Pupil-dilated; 50-degree field of view: 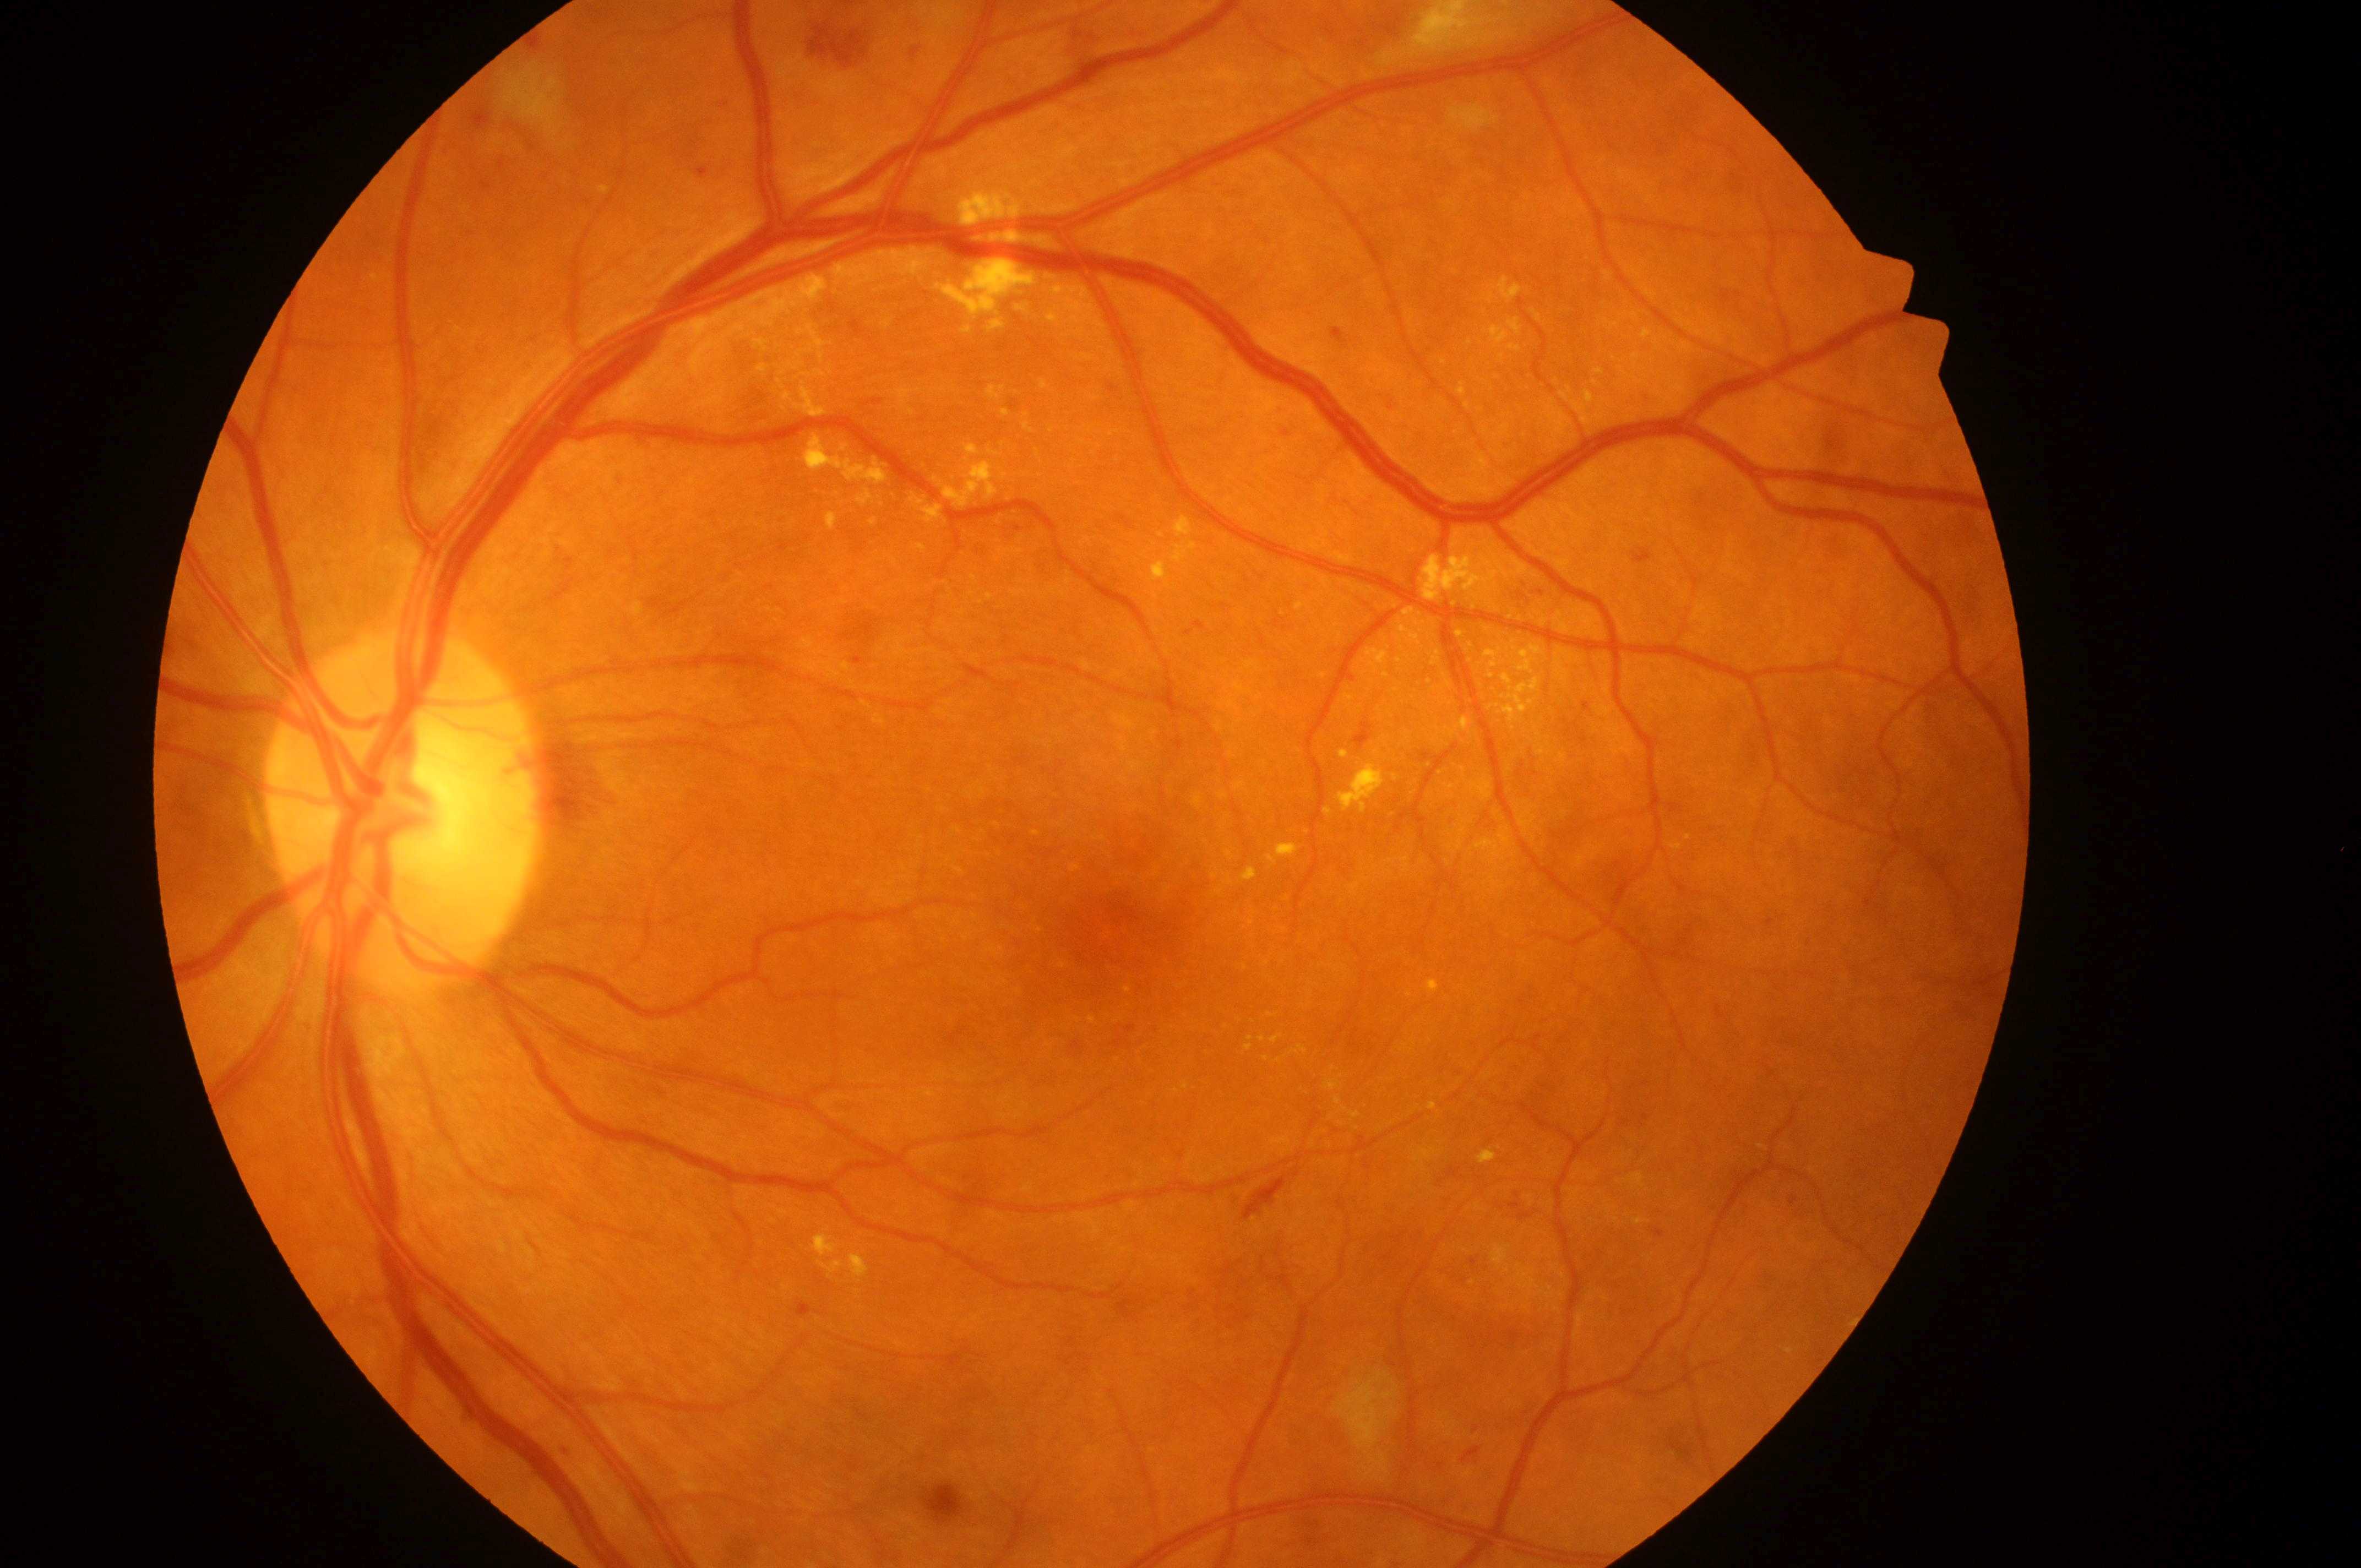 Macular center located at (1124,932).
The optic disc is at (398,823).
Imaged eye: oculus sinister.
Diabetic retinopathy: 3/4.
Diabetic macular edema is grade 2.